45-degree field of view: 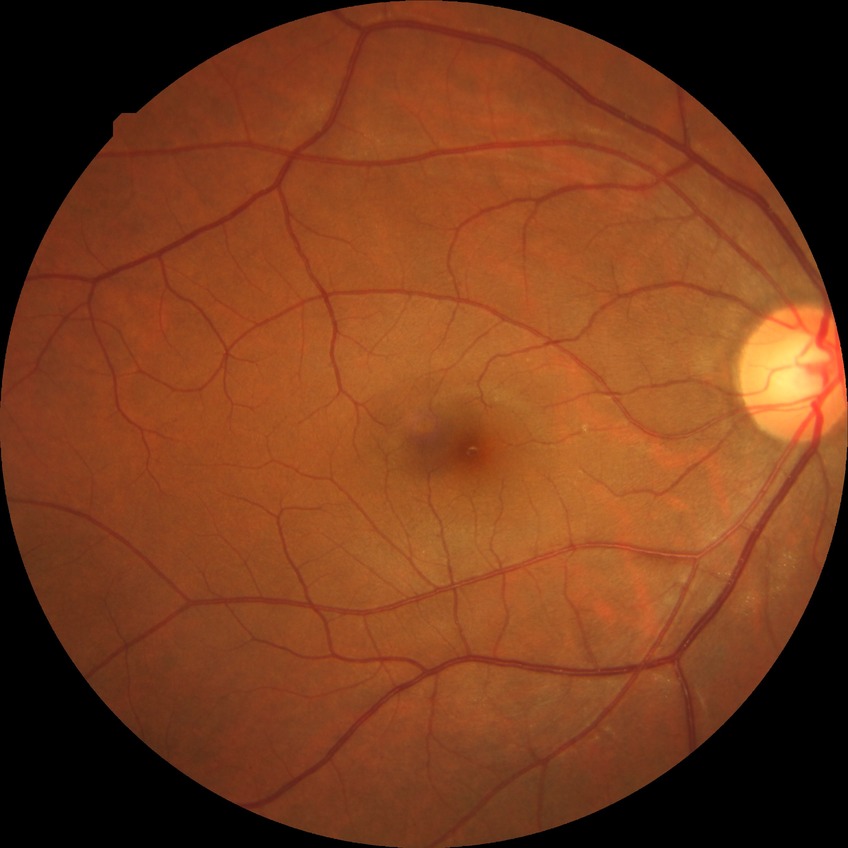 Davis grading is no diabetic retinopathy.